Optic disc photograph — 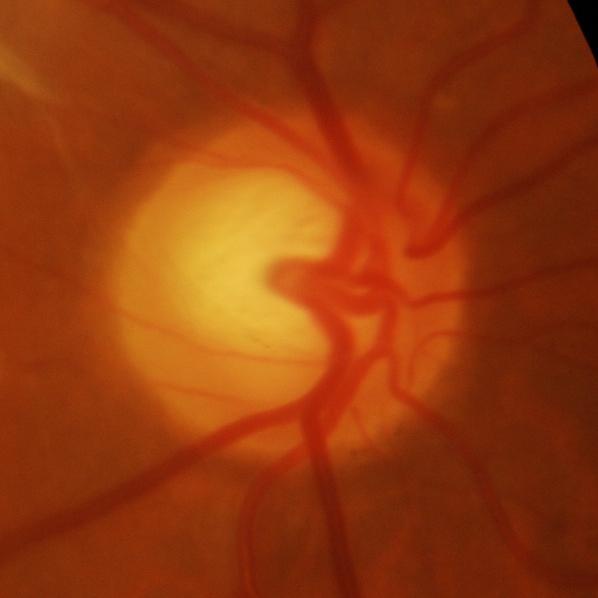 Optic disc appearance consistent with glaucomatous findings.